Wide-field fundus photograph of an infant; captured with the Phoenix ICON (100° field of view)
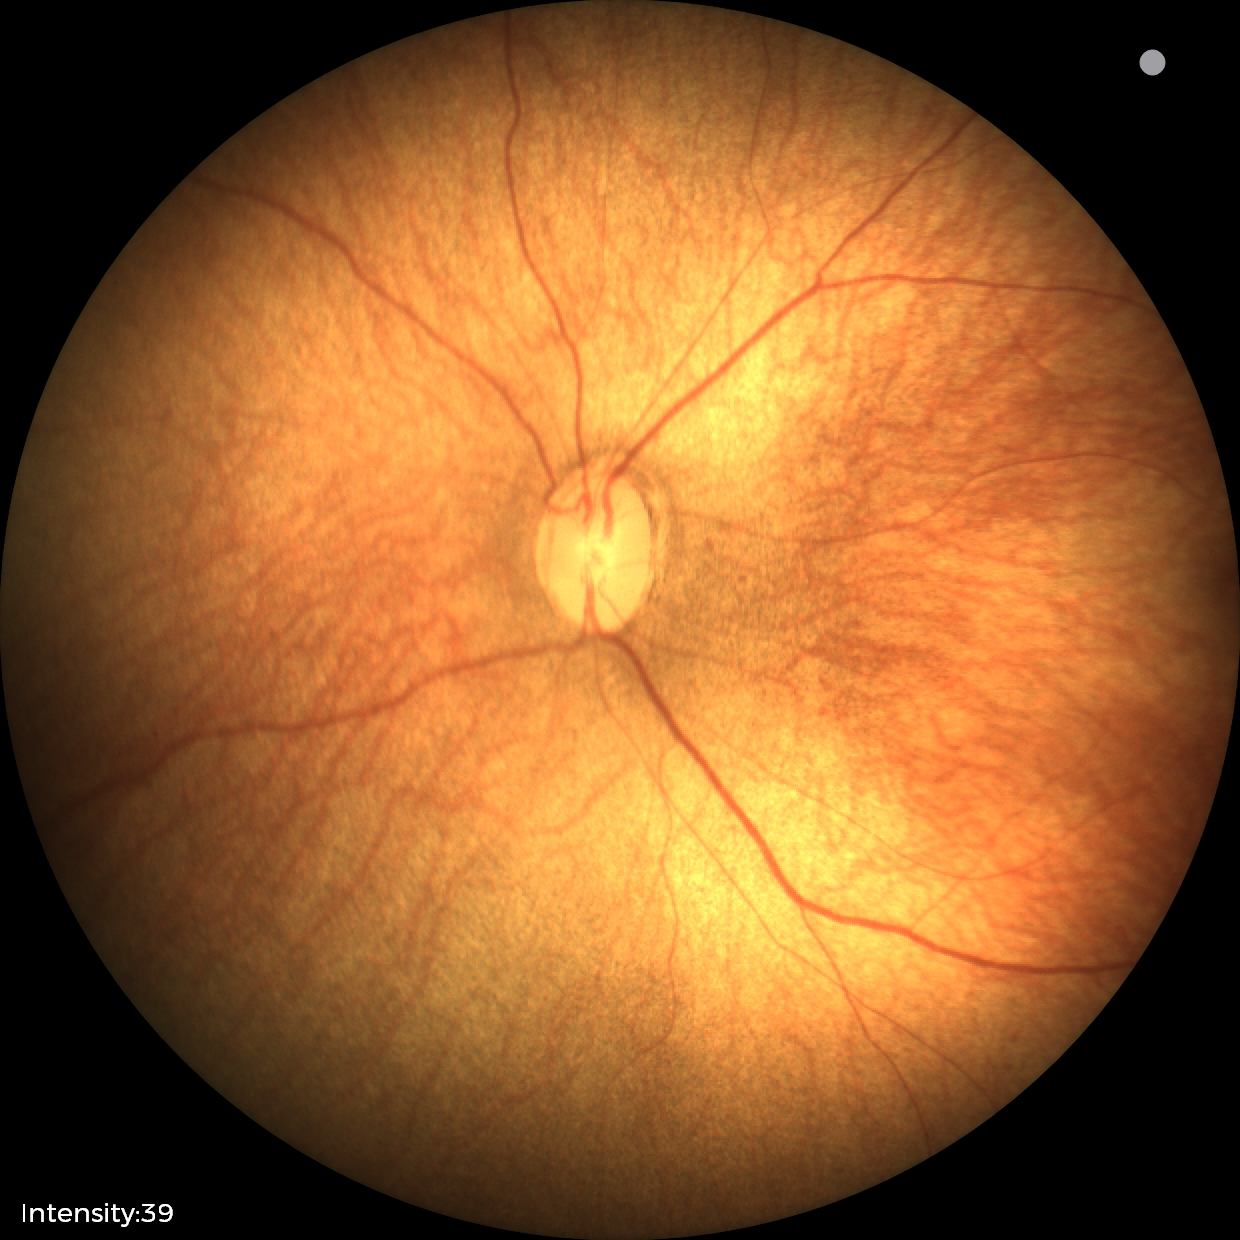 Screening examination diagnosed as physiological.